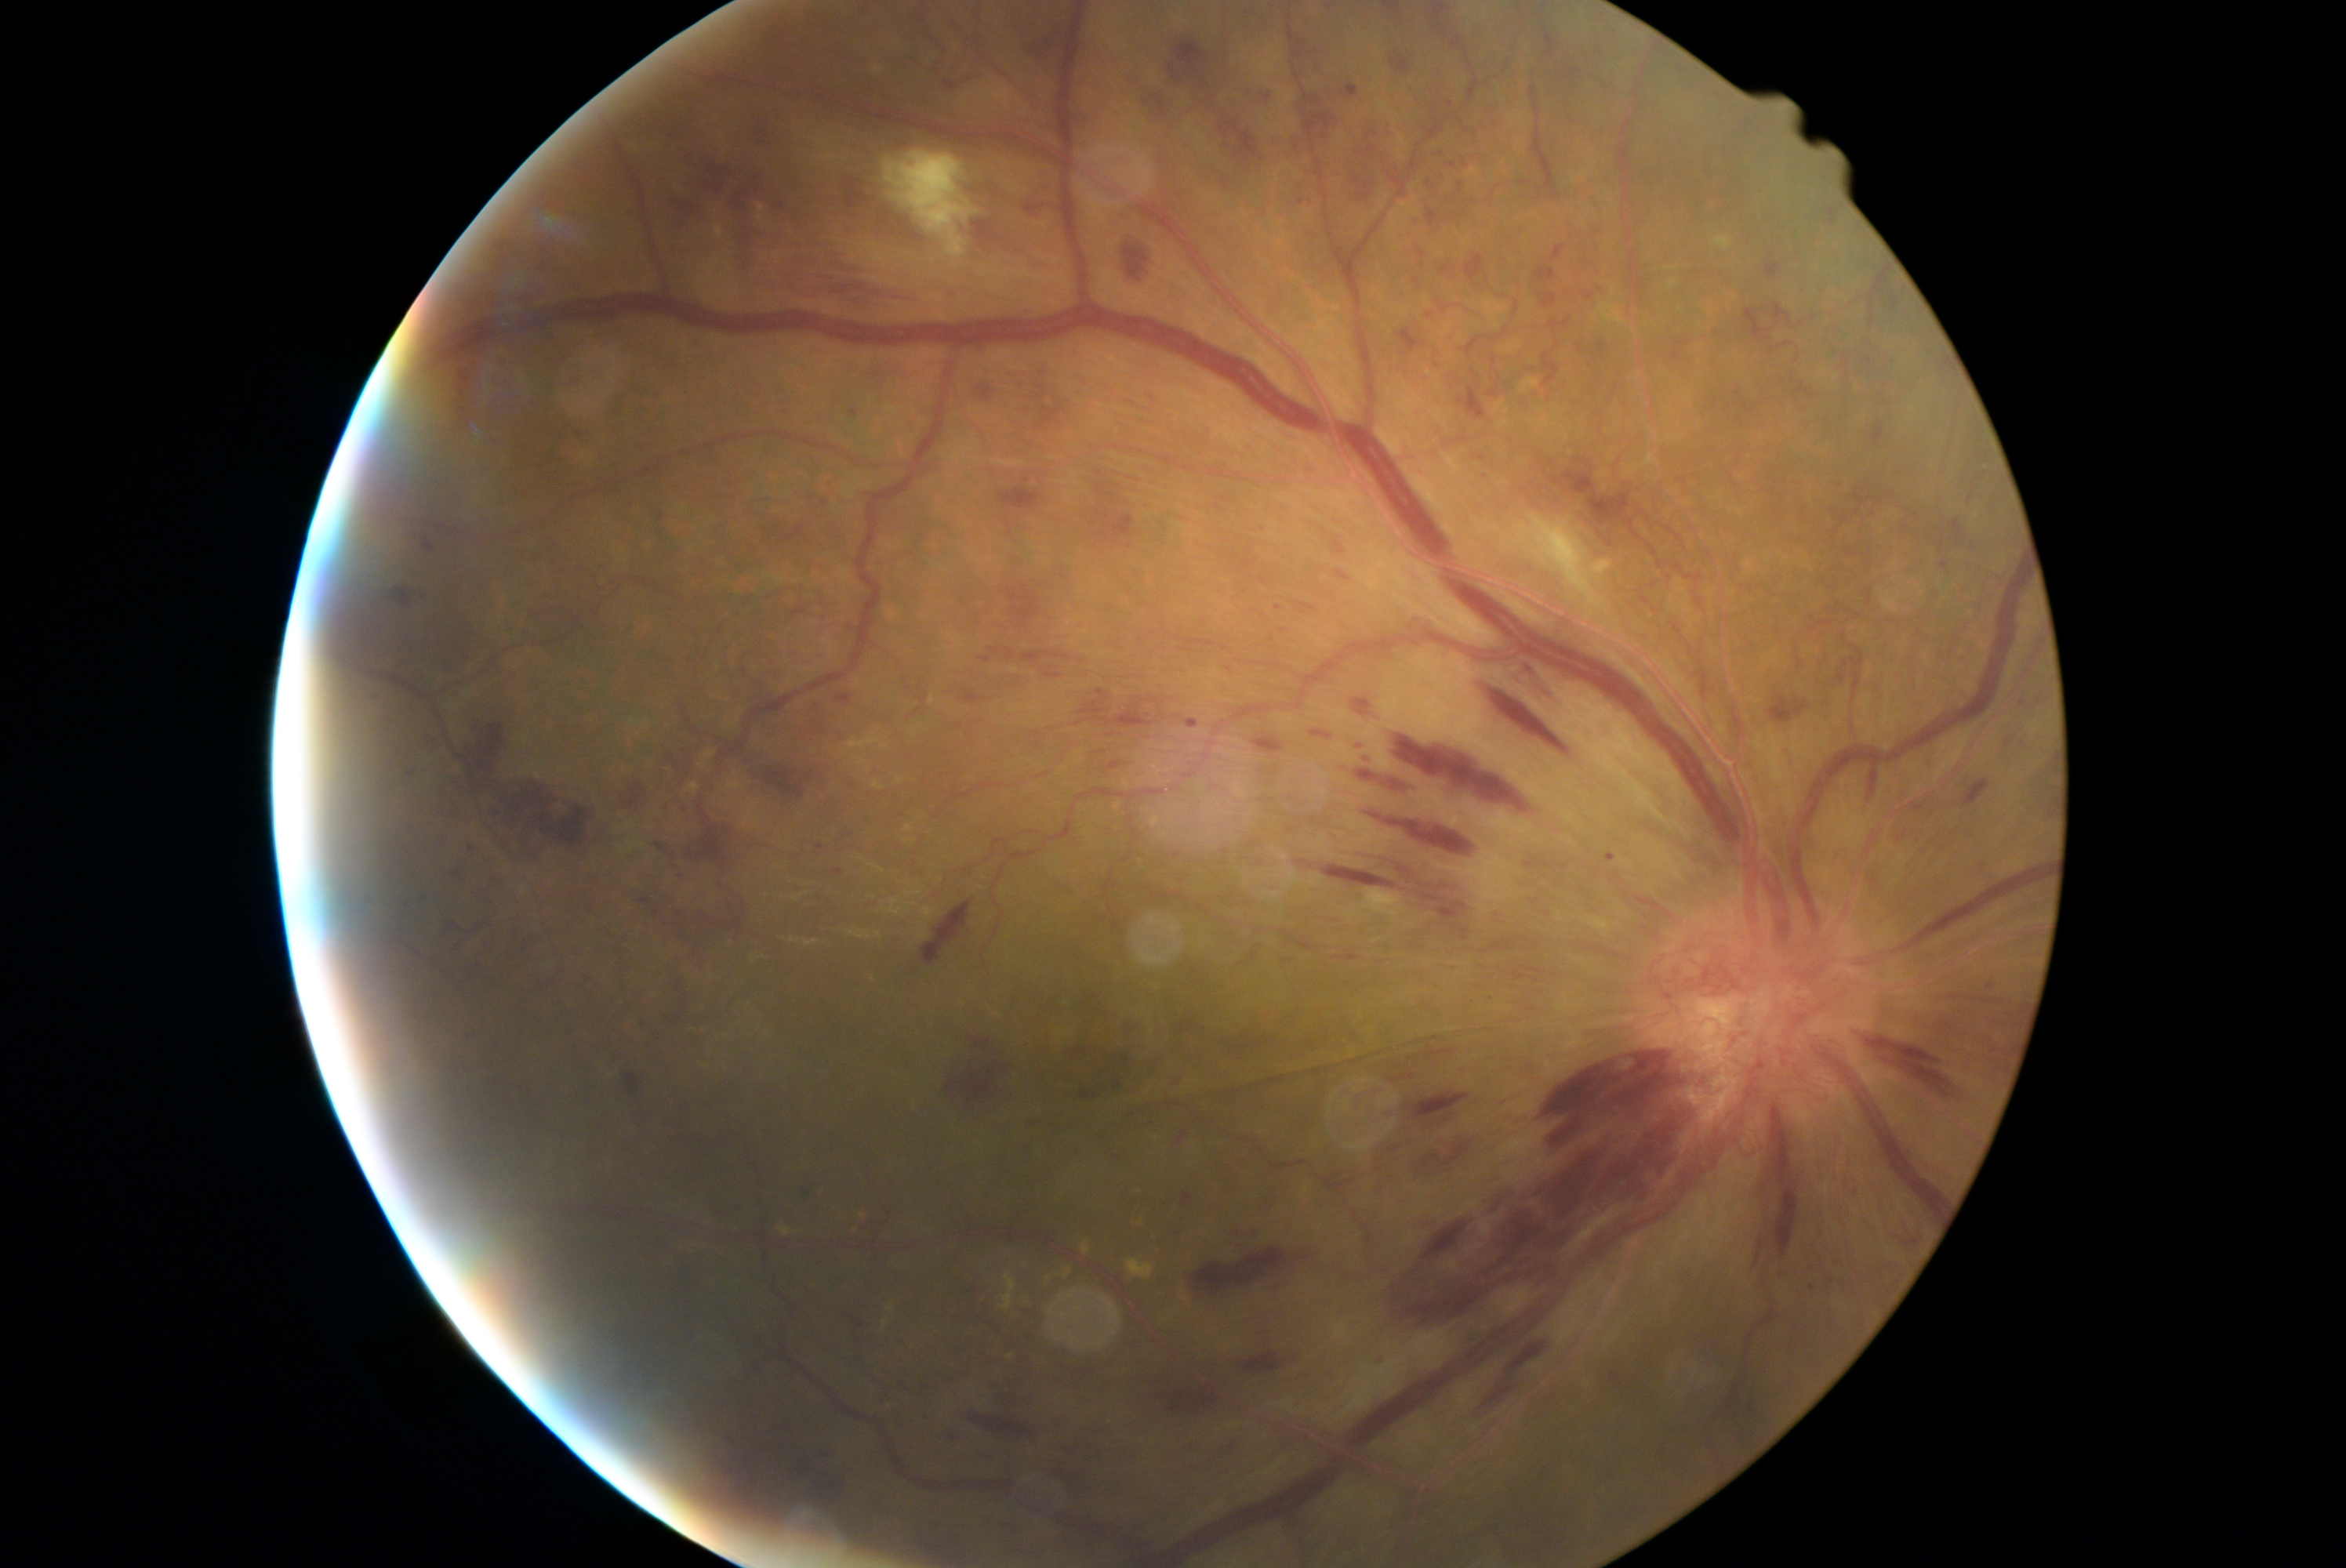 DR grade: 4
Selected lesions:
HEs (partial): l=423, t=736, r=445, b=758, l=1251, t=524, r=1266, b=532, l=788, t=1461, r=804, b=1481, l=1487, t=390, r=1498, b=399, l=1539, t=460, r=1636, b=526, l=1155, t=95, r=1166, b=112, l=990, t=1377, r=1026, b=1410, l=755, t=763, r=819, b=799, l=1243, t=739, r=1288, b=755, l=1302, t=96, r=1335, b=142, l=371, t=694, r=382, b=700, l=1095, t=473, r=1141, b=545, l=1375, t=1356, r=1387, b=1368, l=449, t=868, r=467, b=882, l=1081, t=1426, r=1117, b=1437, l=1384, t=727, r=1542, b=824, l=816, t=1475, r=844, b=1506
HEs (small, approximate centers) near (2041,698), (1423,266), (1831,1279)